2346x1568px · CFP · 45-degree field of view — 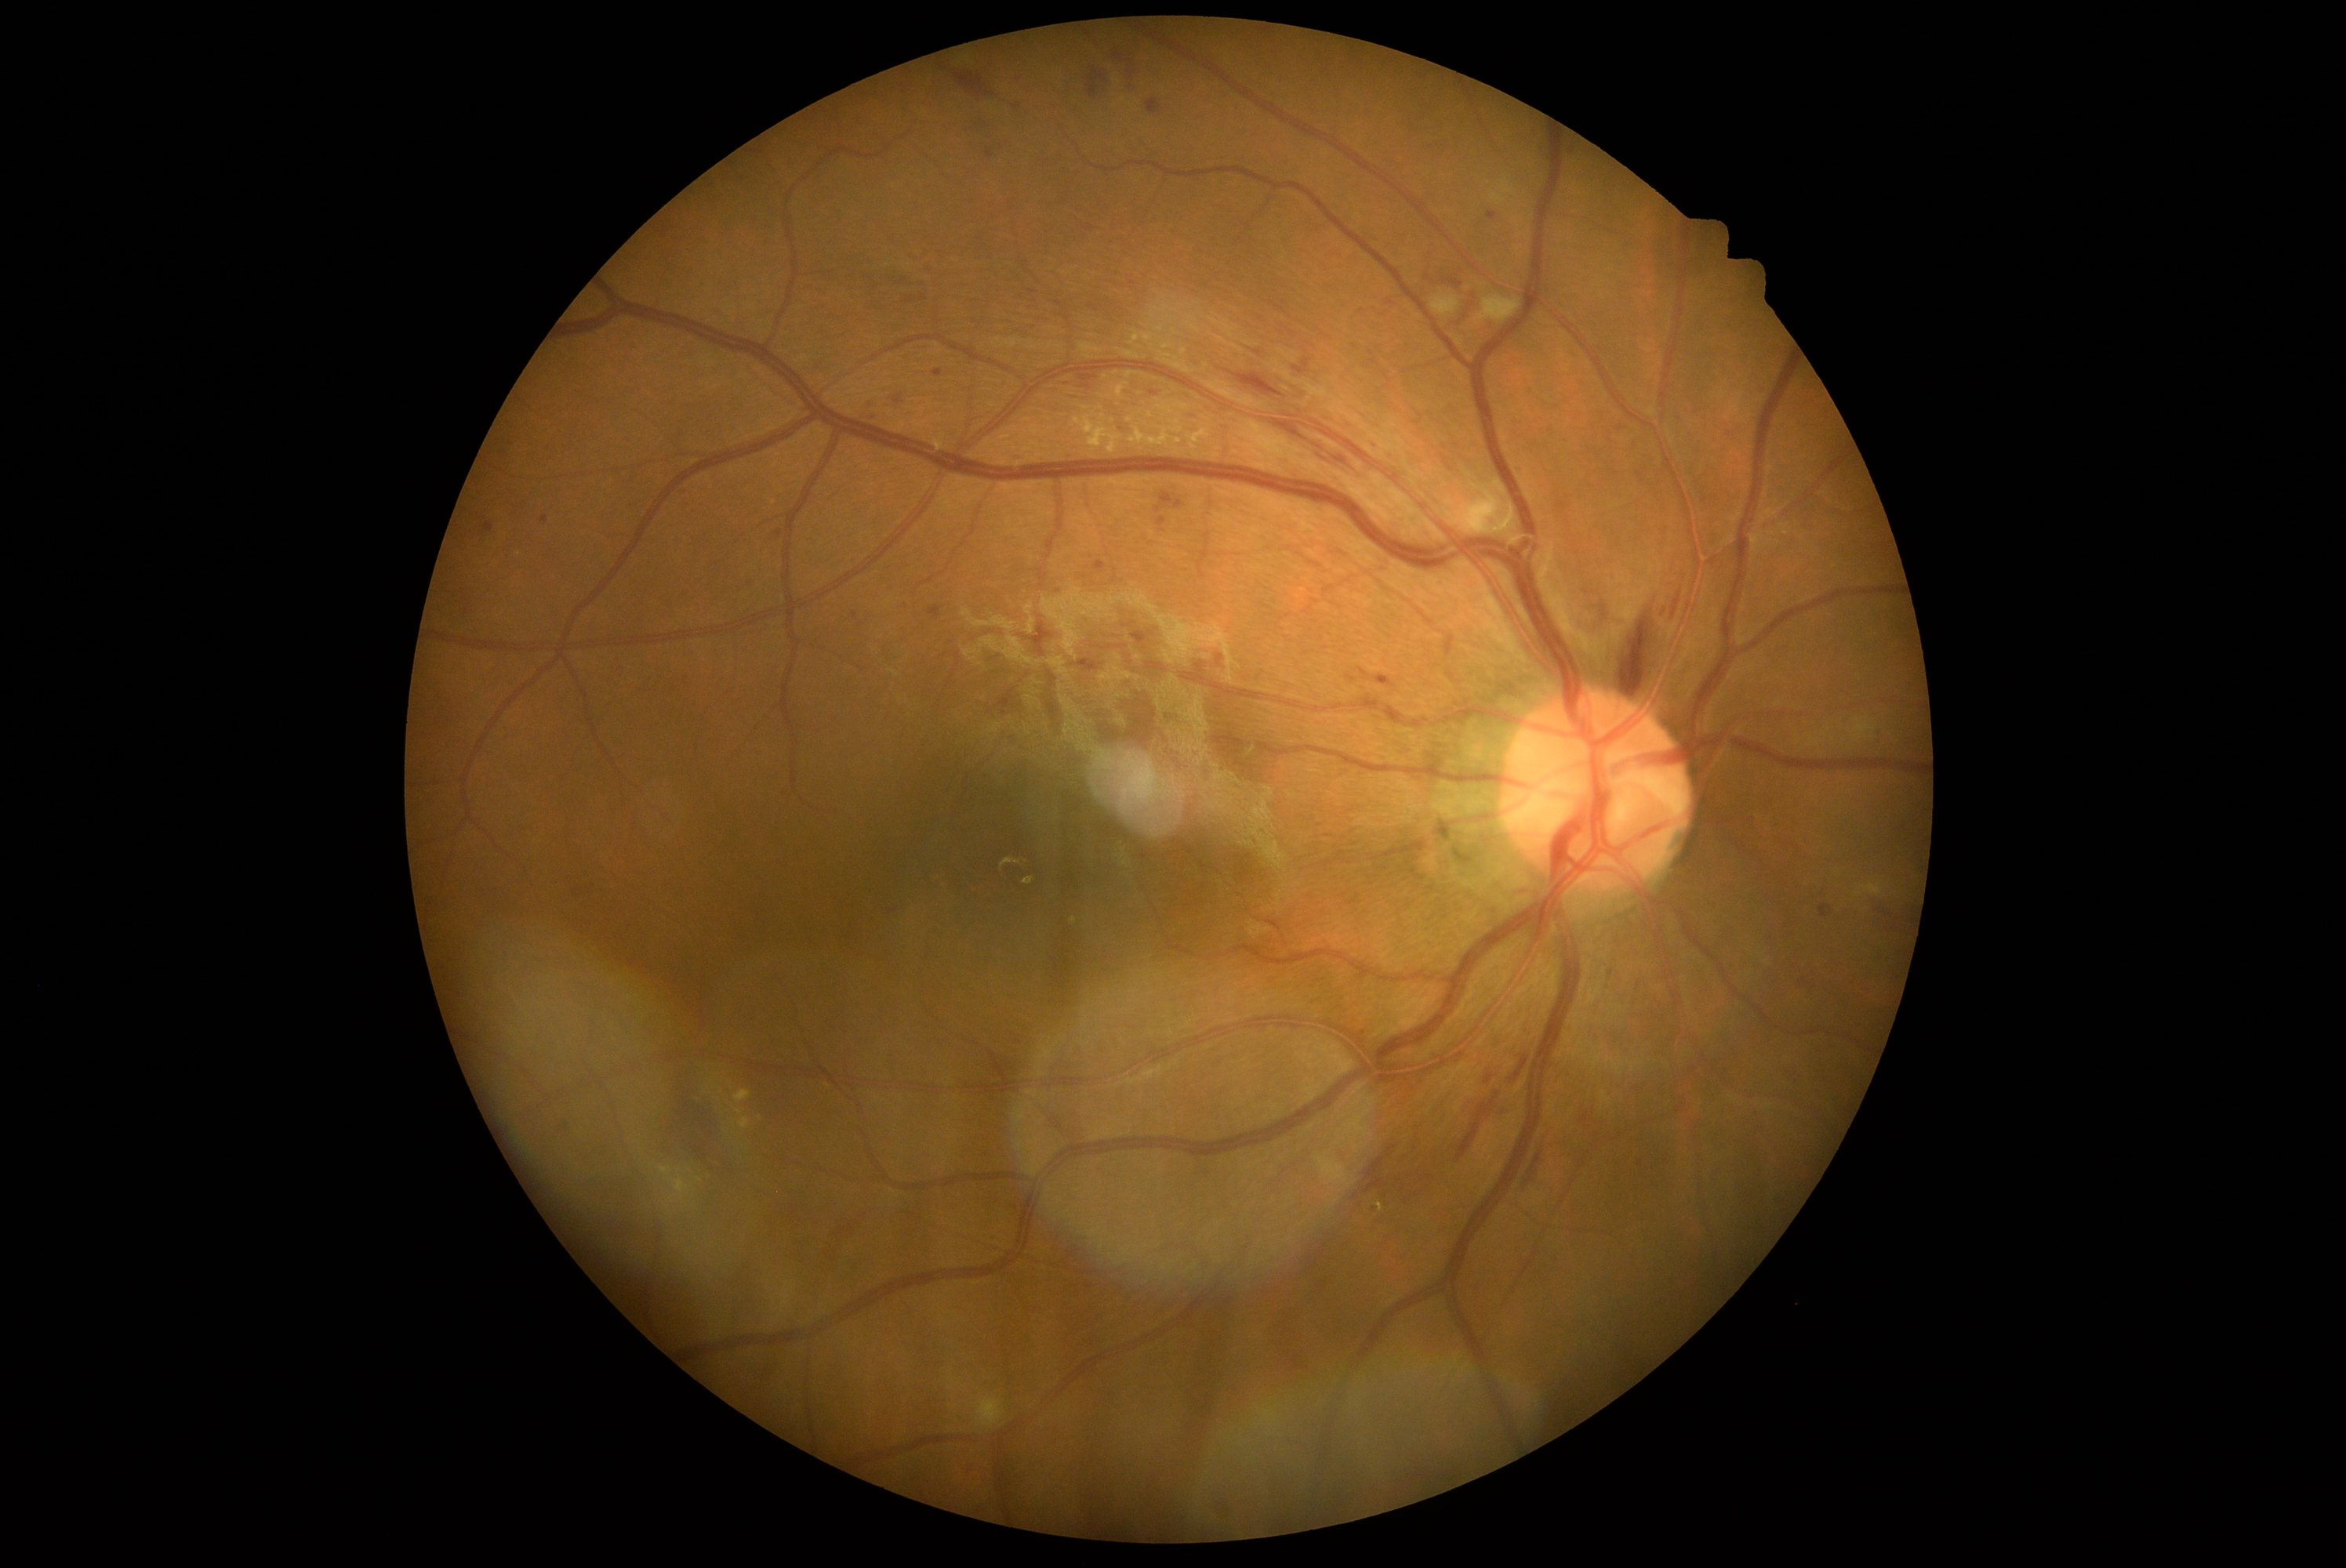
Diabetic retinopathy severity is 2.